FOV: 45 degrees; color fundus image
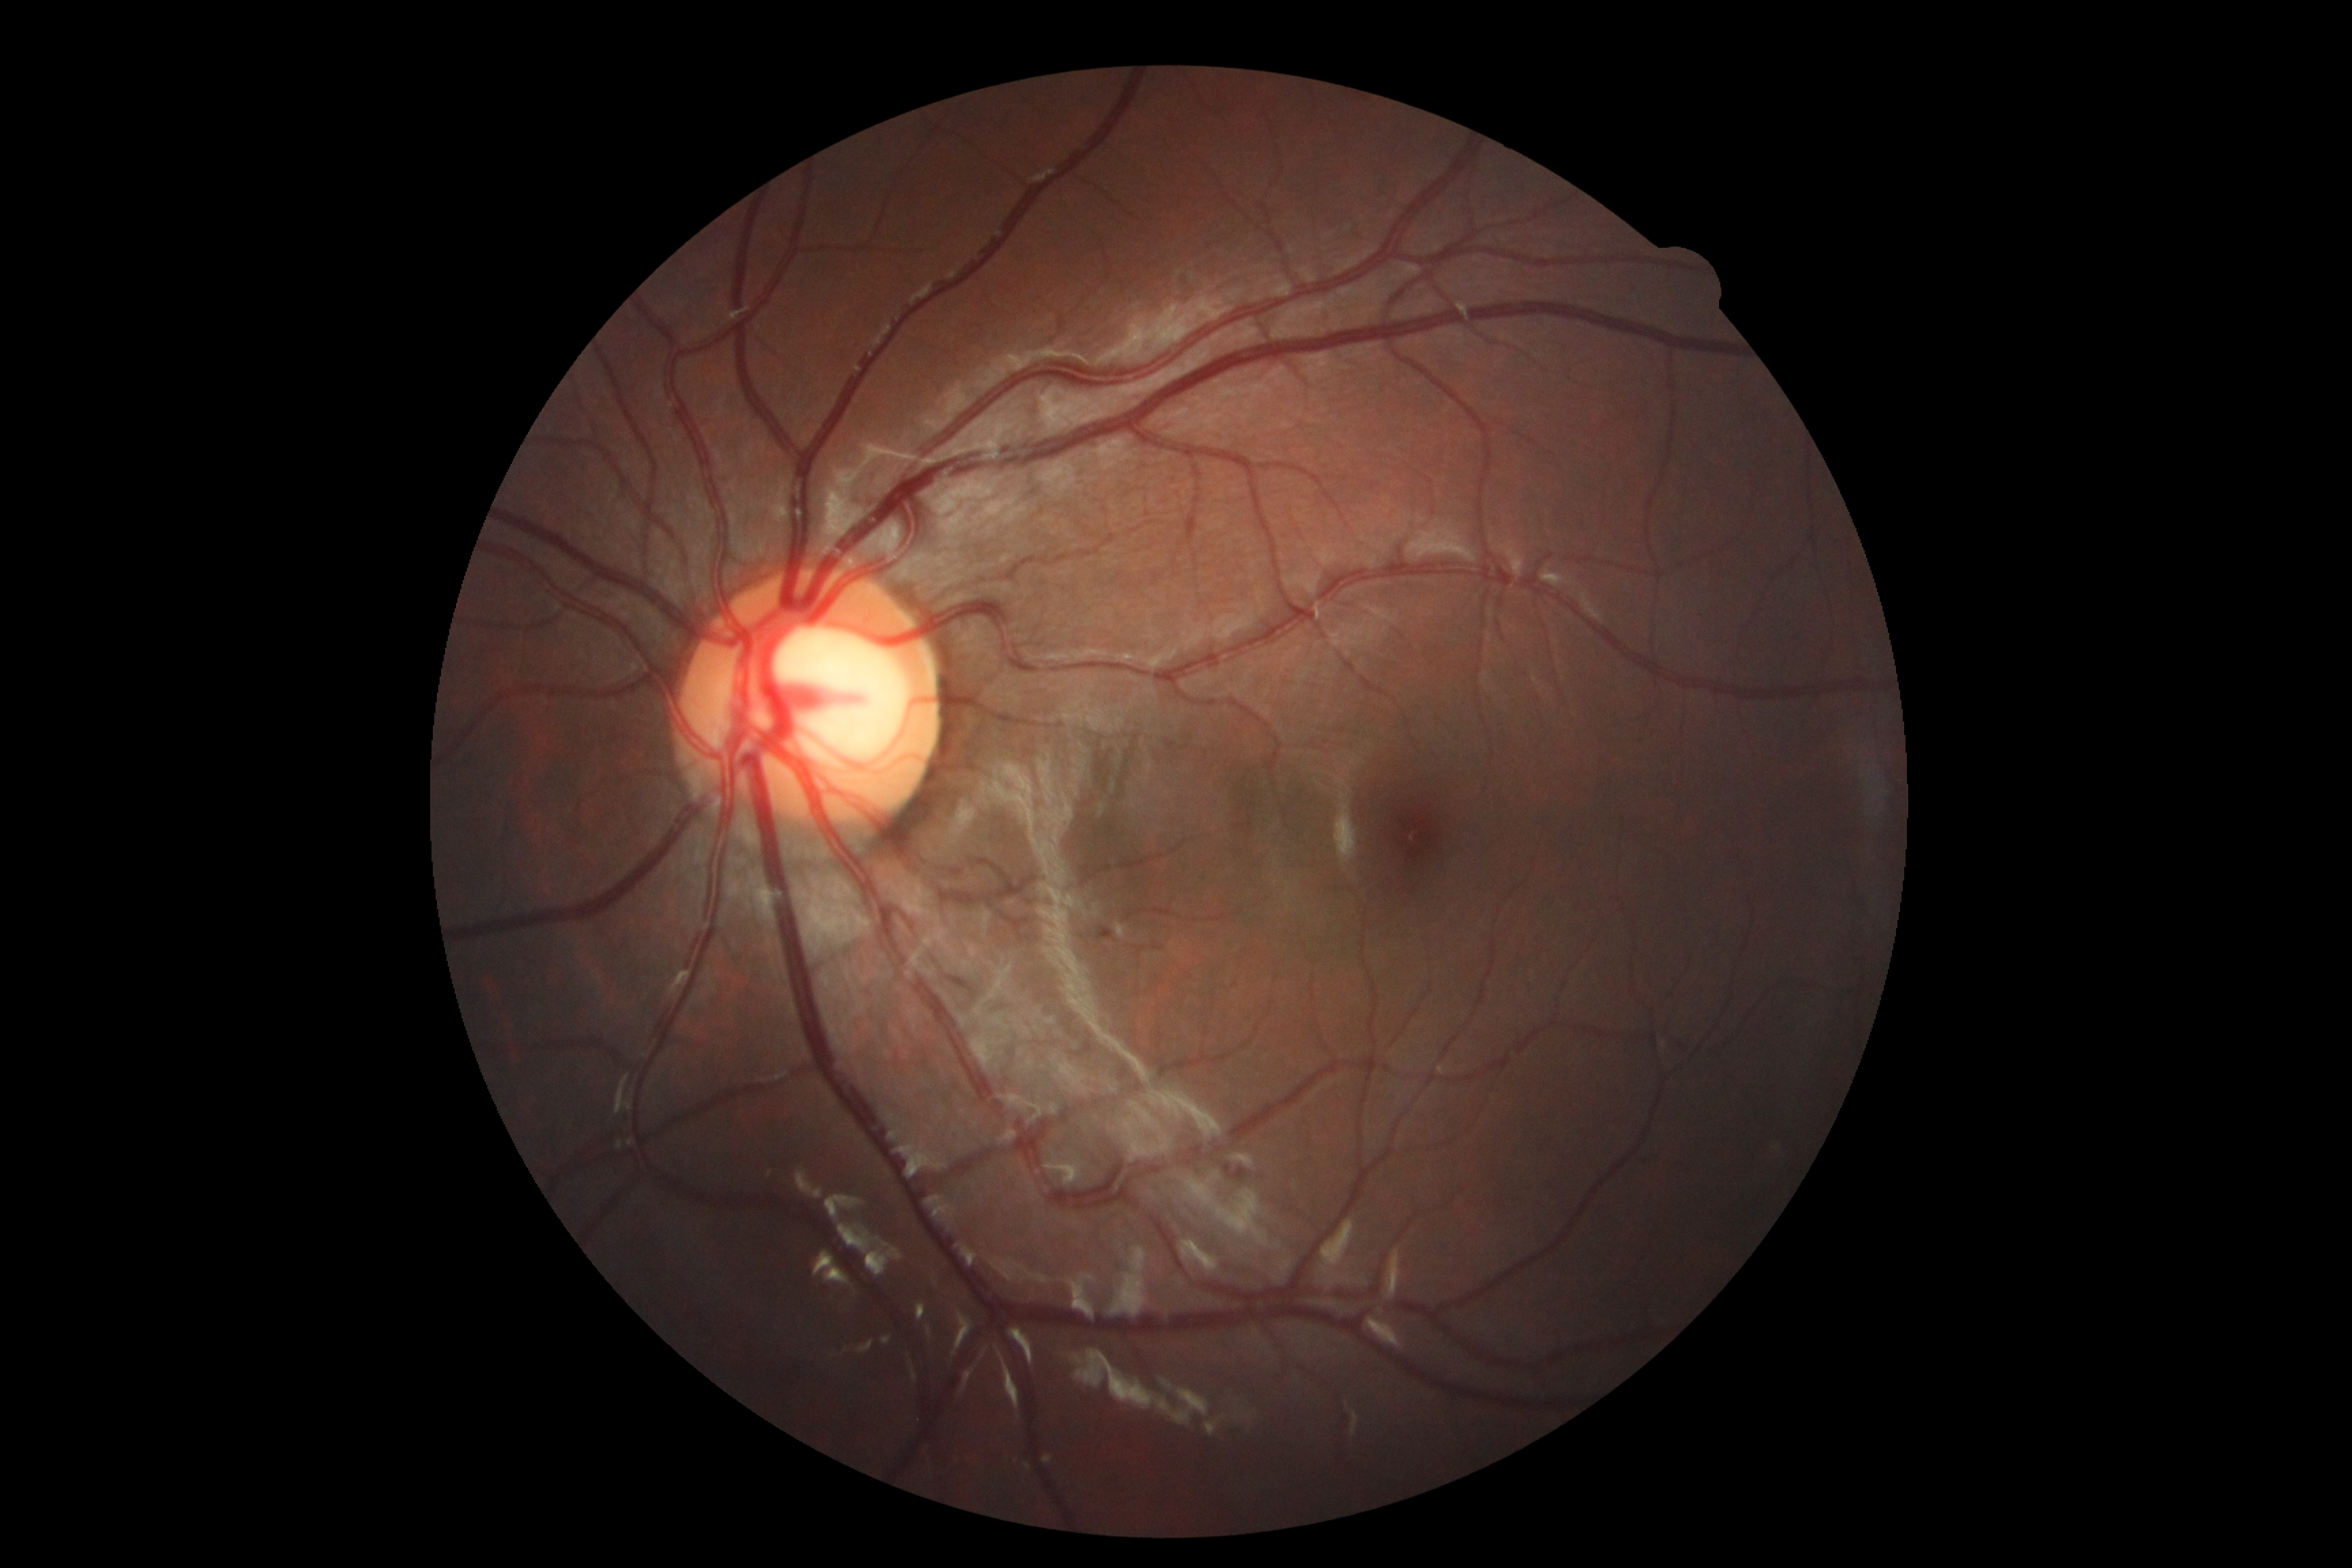
Findings:
- DR: grade 0 — no visible signs of diabetic retinopathy